Fundus photo.
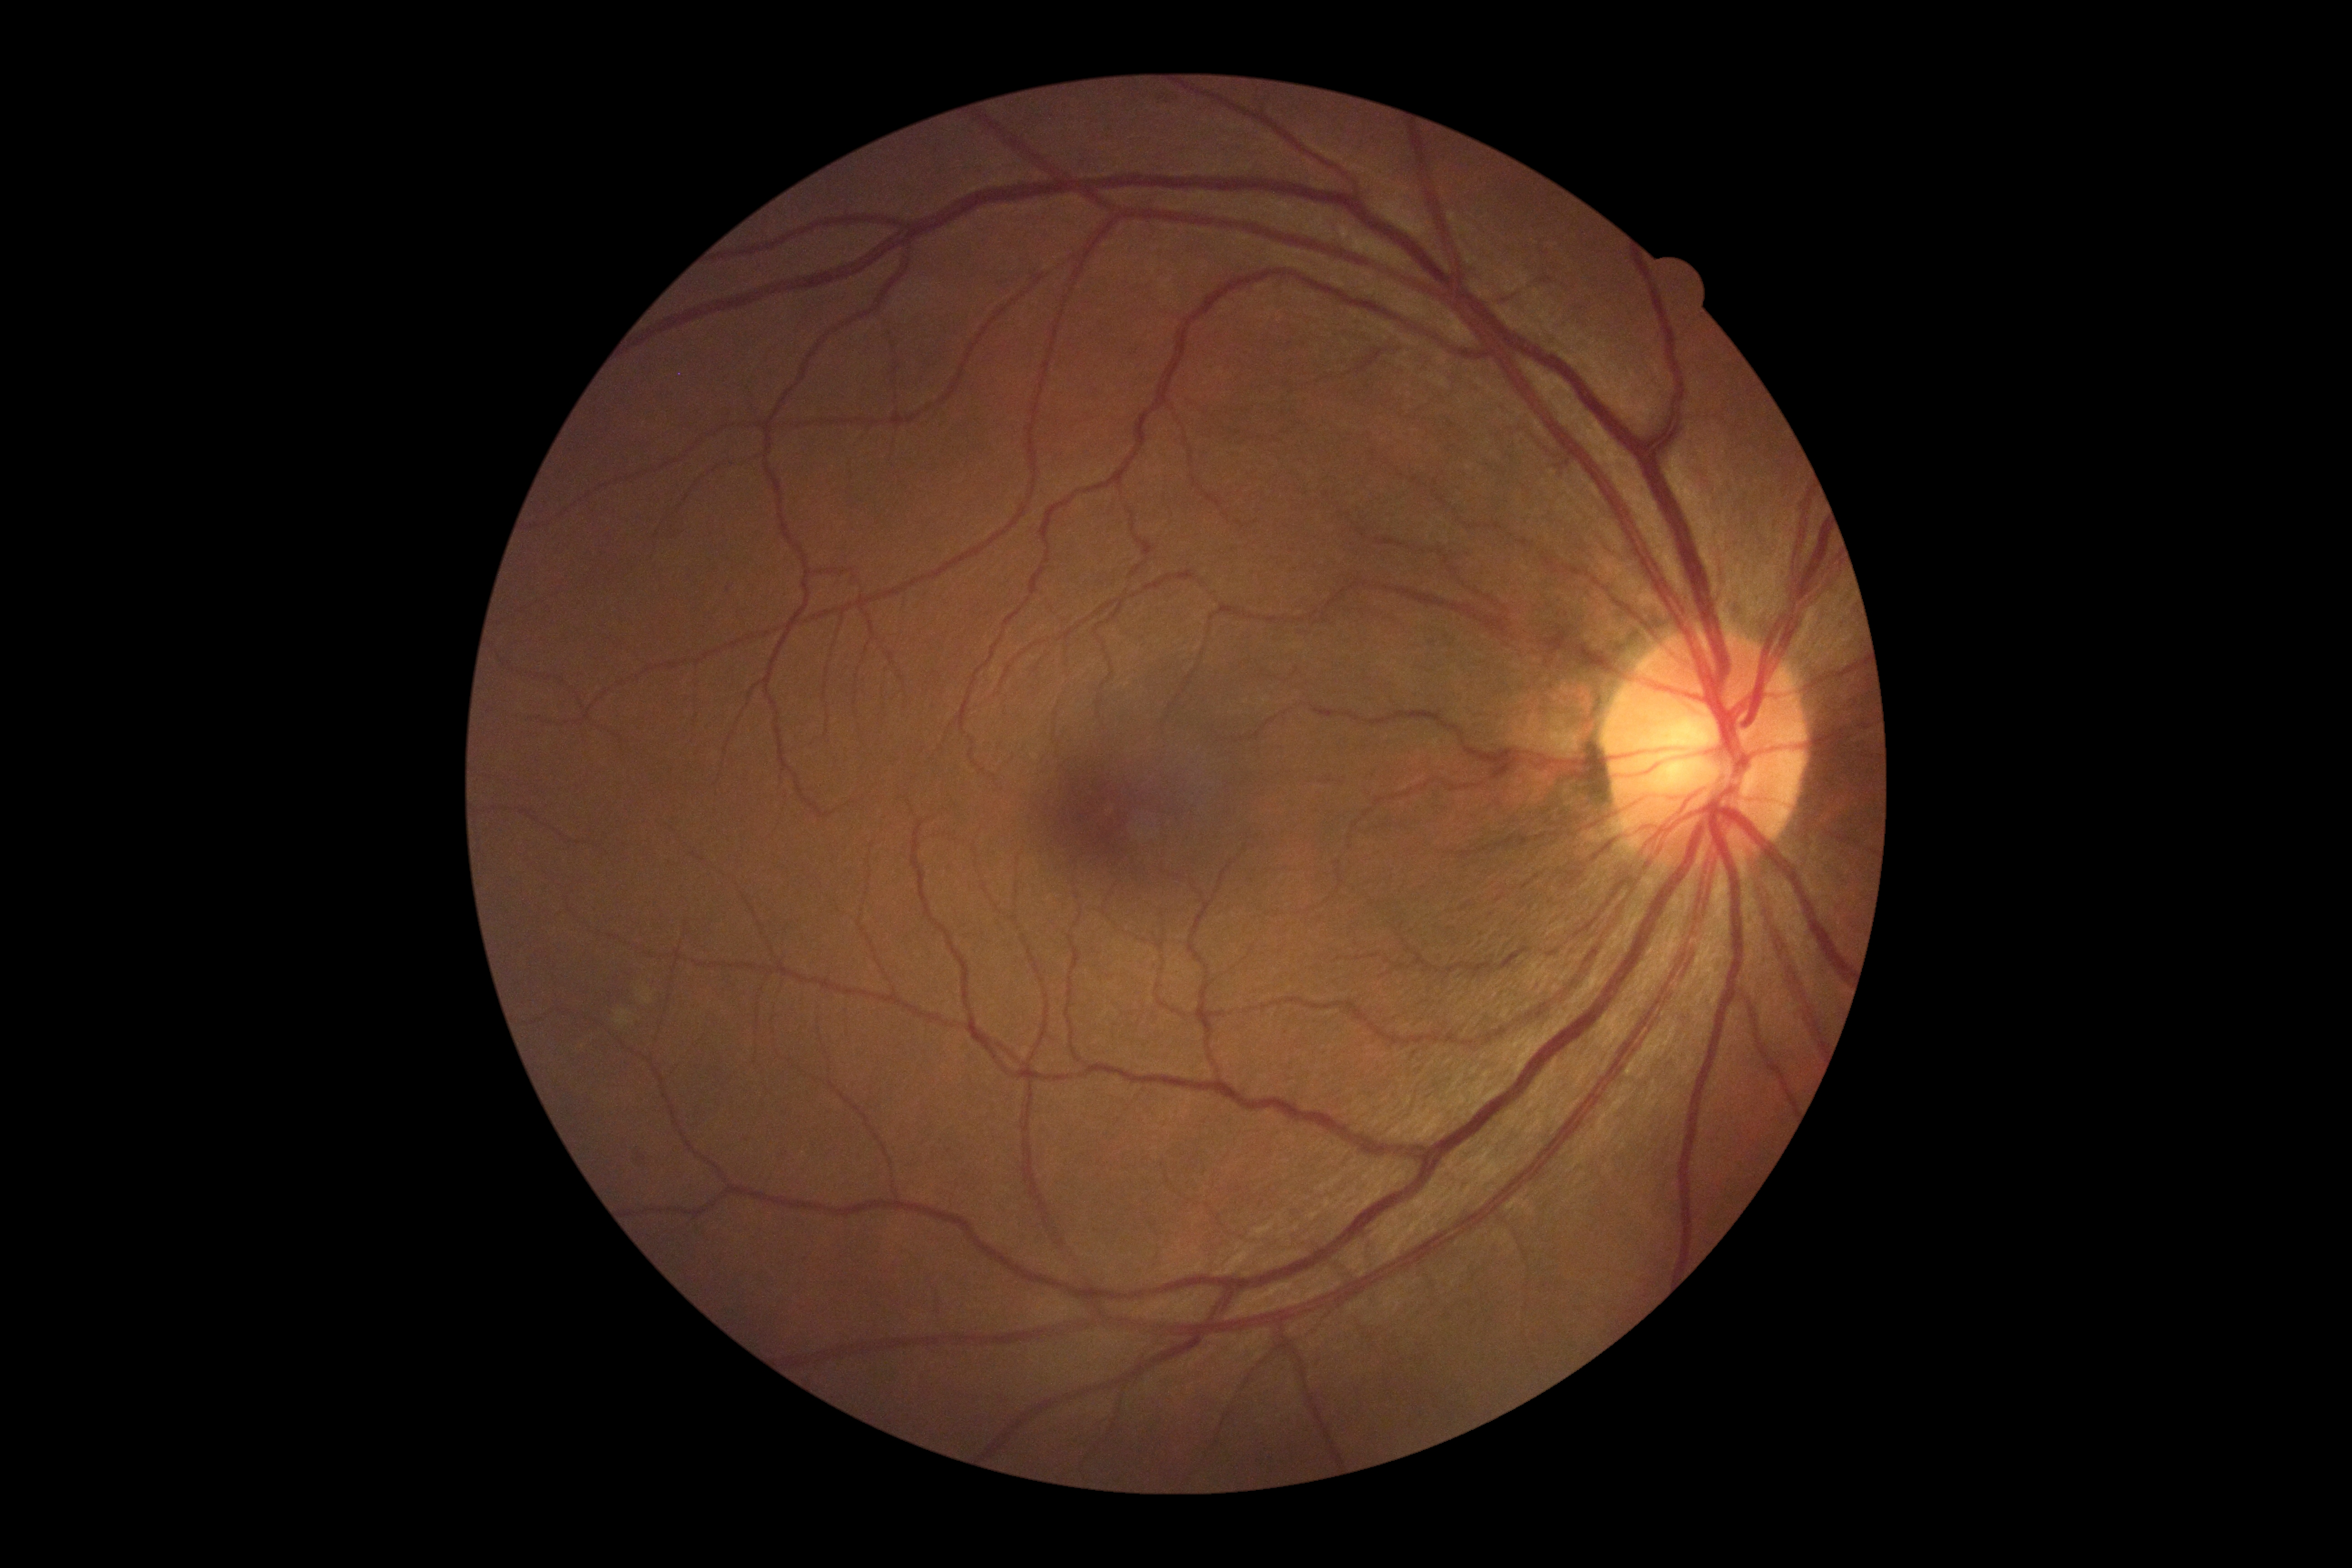

{"dr_grade": "grade 0 (no apparent retinopathy)"}